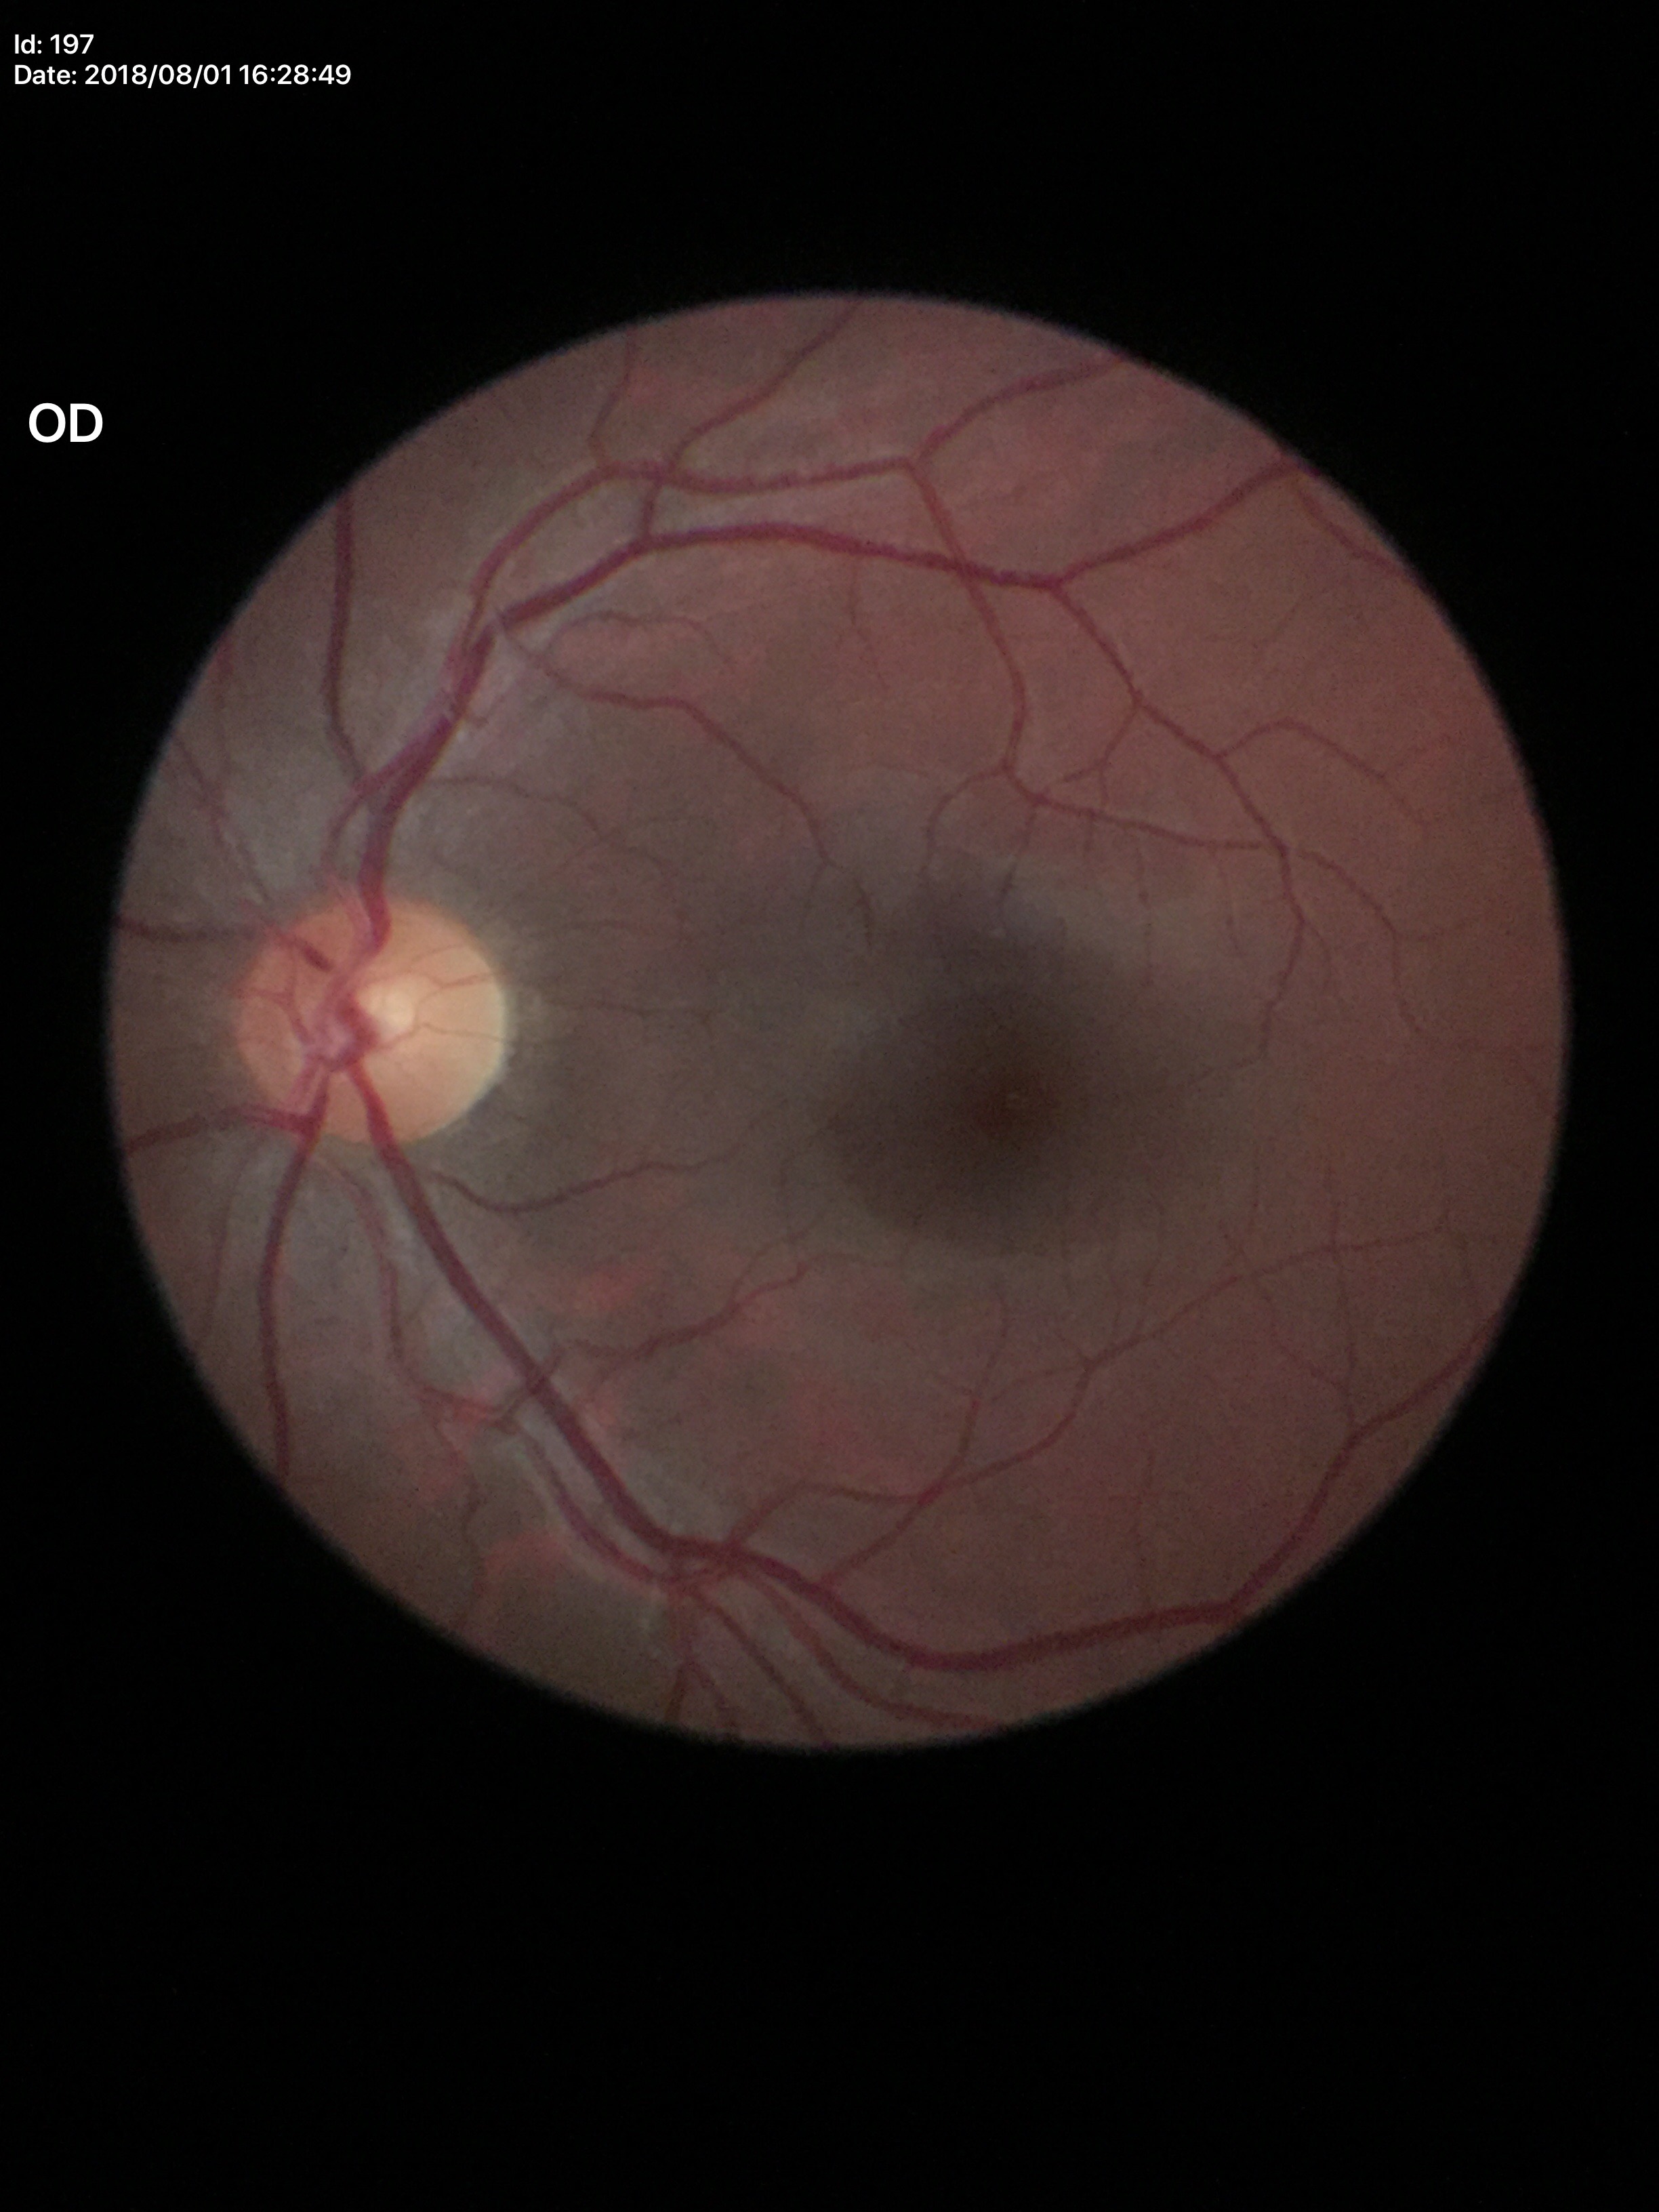 Glaucoma screening: not suspect; horizontal cup-disc ratio (HCDR): 0.47; vertical cup-to-disc ratio (VCDR): 0.48